Image size 848x848; 45° field of view.
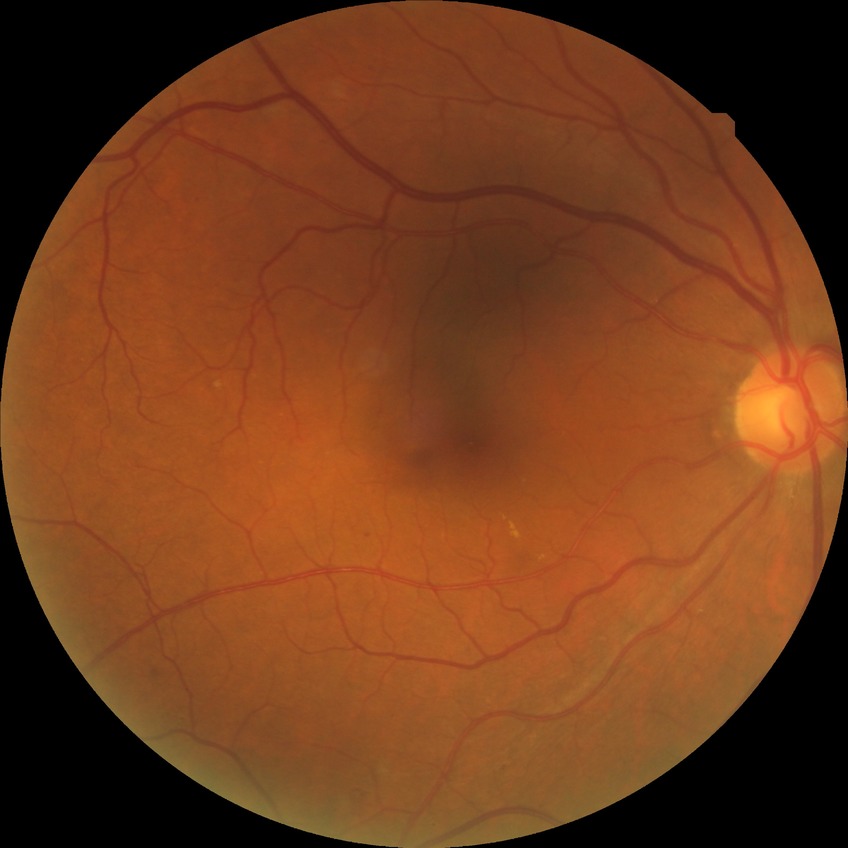
Diabetic retinopathy (DR) is SDR (simple diabetic retinopathy).